45° FOV · 1932 by 1932 pixels · fundus photo
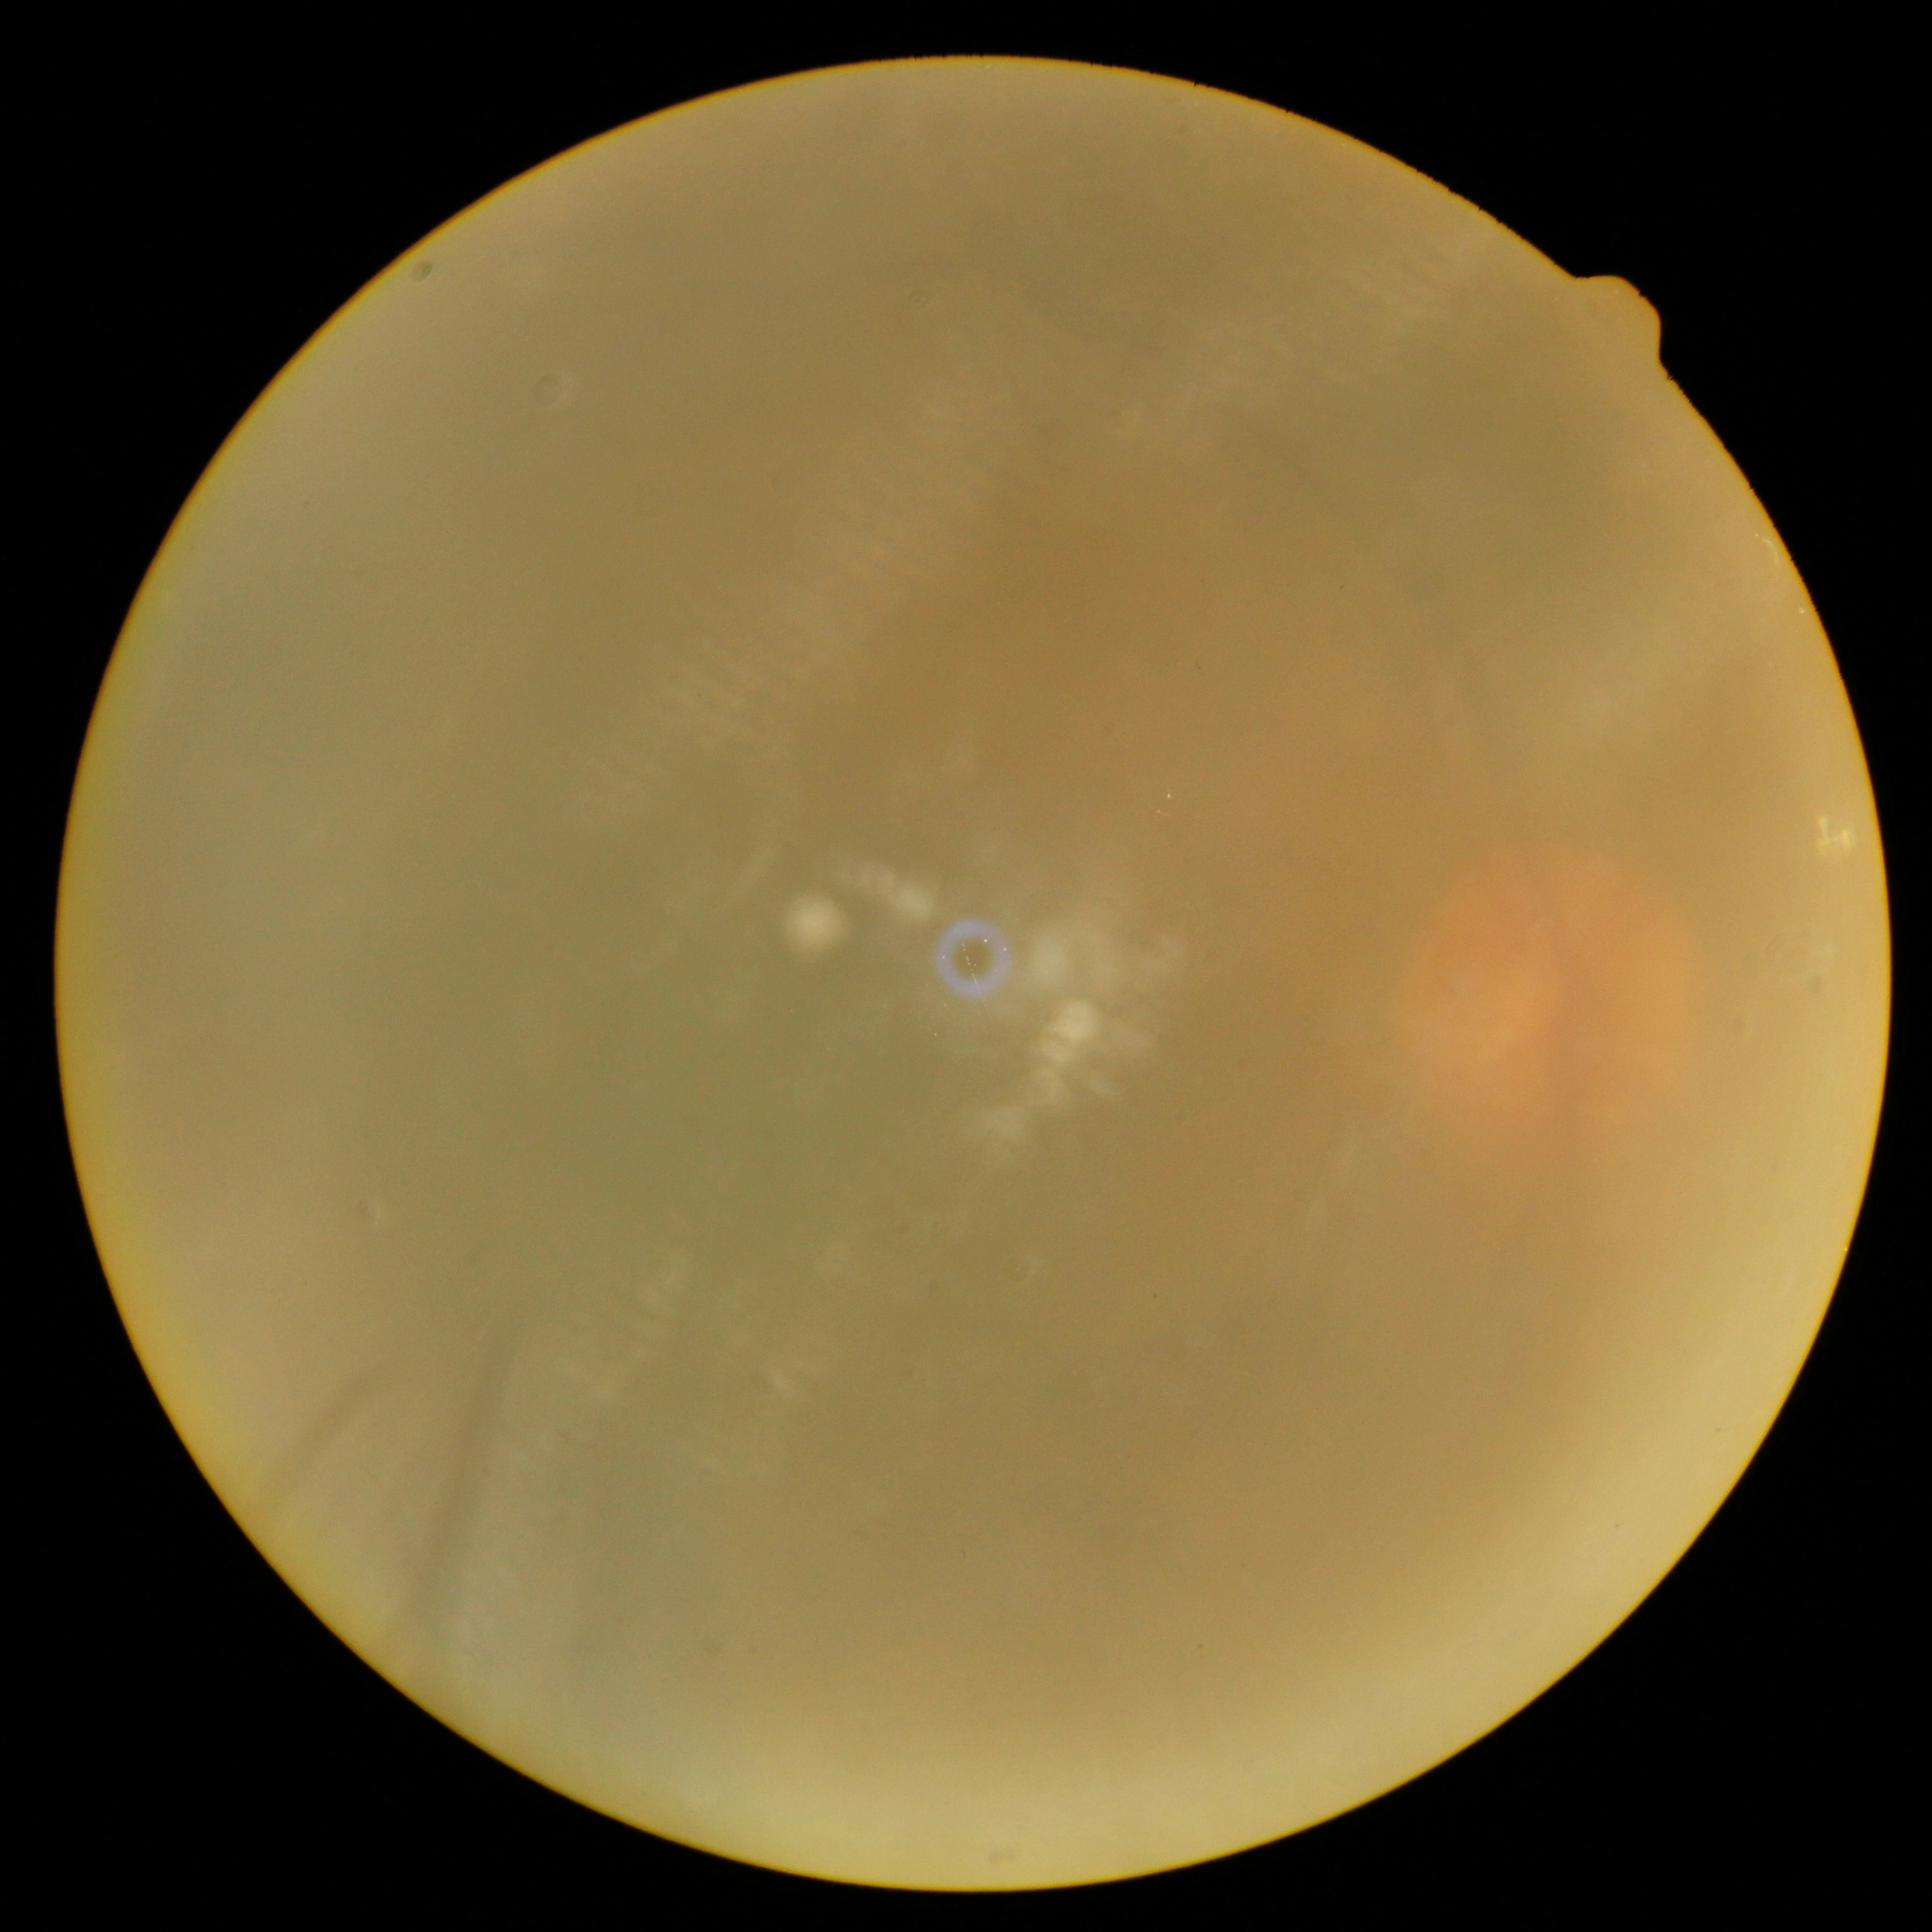
DR stage is ungradable. Ungradable image — DR severity cannot be determined.